No pharmacologic dilation; posterior pole color fundus photograph; 848 x 848 pixels; graded on the modified Davis scale — 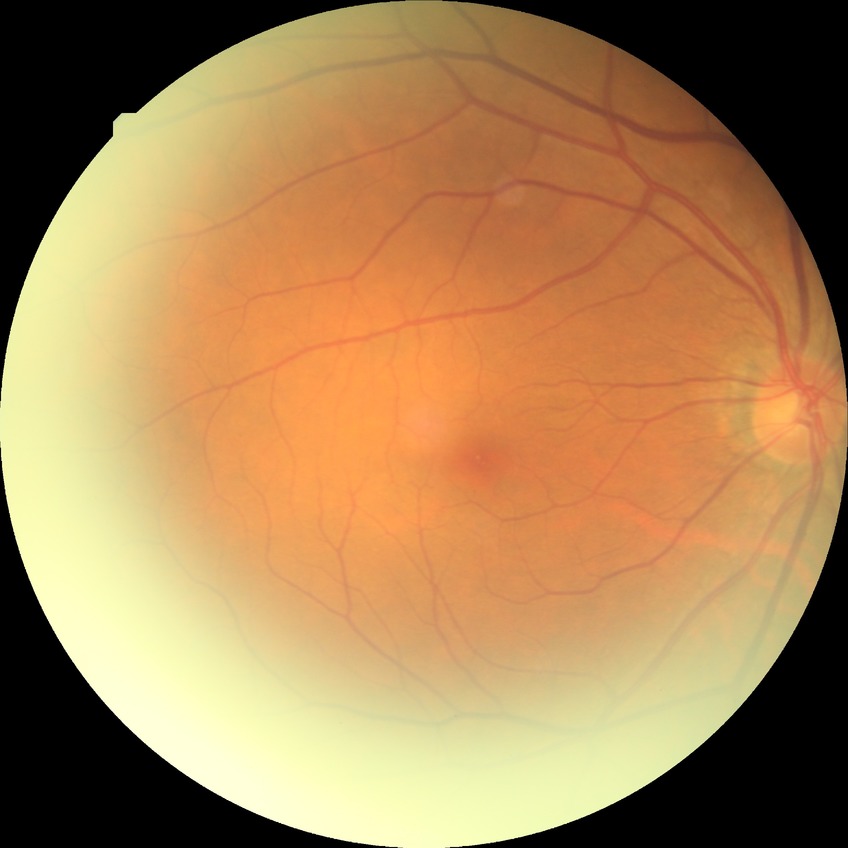

diabetic retinopathy (DR): NDR (no diabetic retinopathy).